2352x1568 — 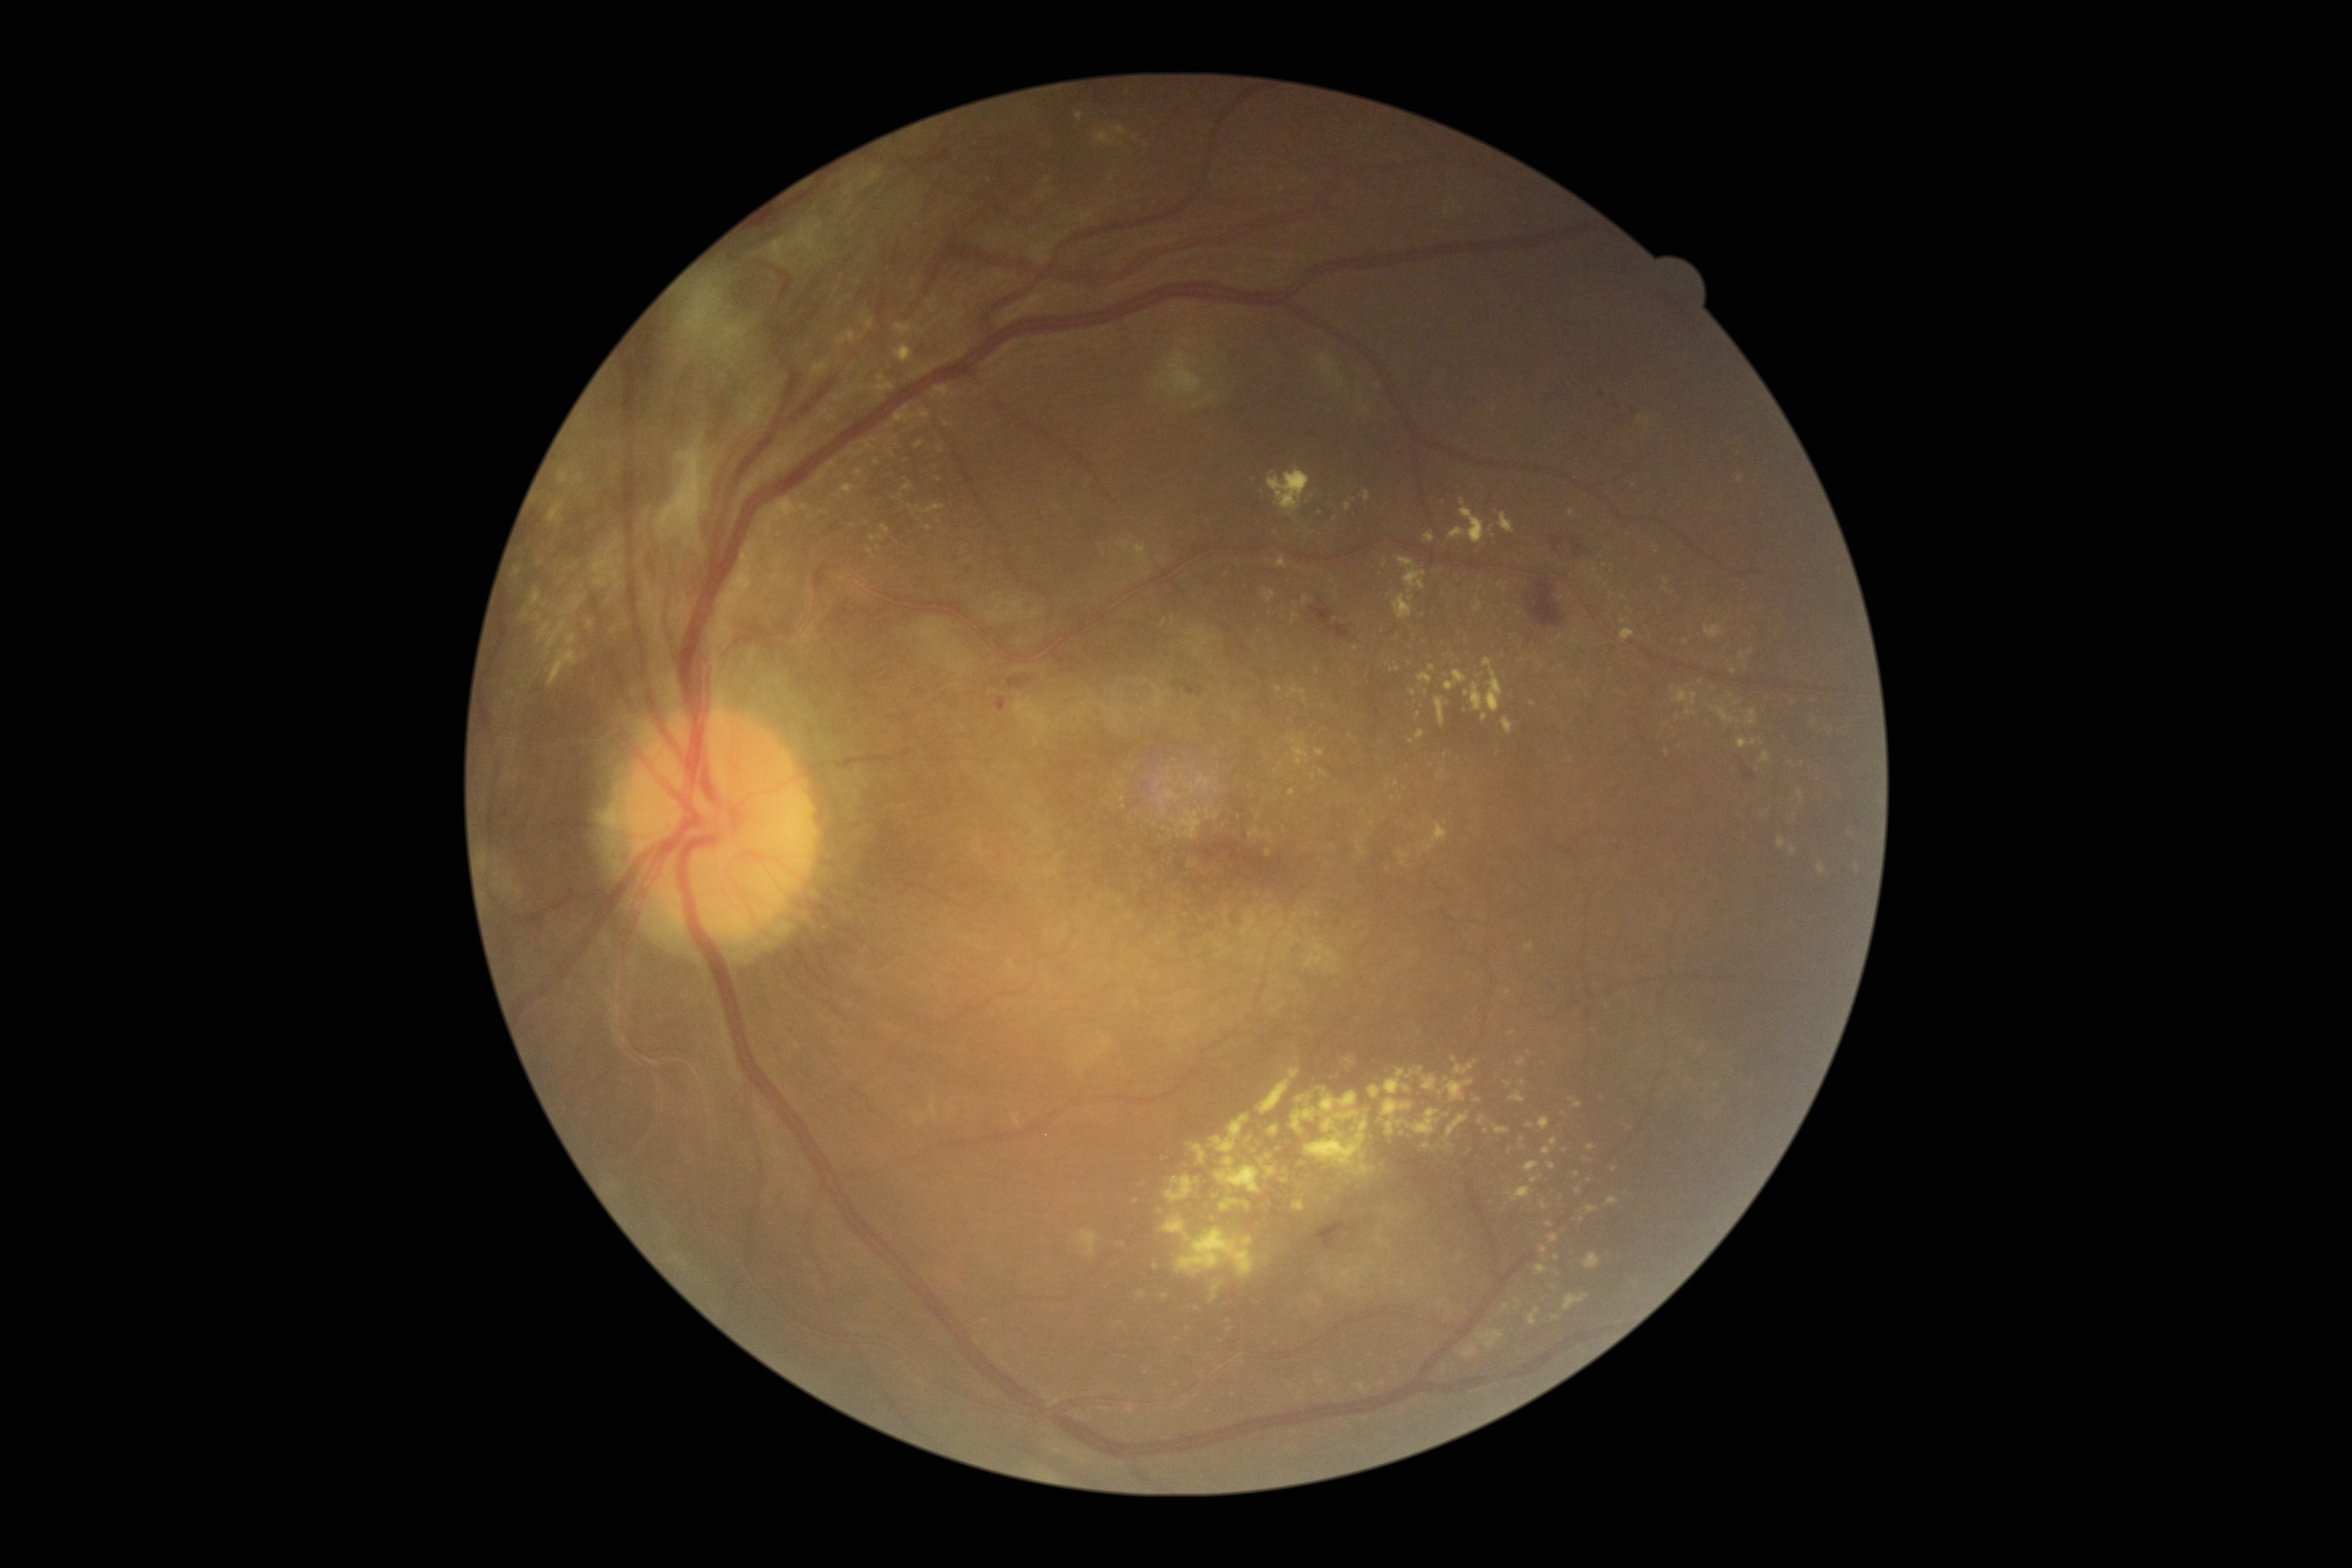

Diabetic retinopathy grade is 4 (PDR) — neovascularization and/or vitreous/pre-retinal hemorrhage
Representative lesions:
• hard exudates (partial): left=1509, top=1091, right=1525, bottom=1103; left=1422, top=1074, right=1438, bottom=1091; left=1760, top=751, right=1771, bottom=764; left=1549, top=1233, right=1559, bottom=1242; left=1478, top=1116, right=1485, bottom=1126; left=1382, top=1099, right=1414, bottom=1135; left=1423, top=822, right=1448, bottom=851; left=1586, top=1204, right=1599, bottom=1213; left=834, top=331, right=857, bottom=349; left=1740, top=653, right=1746, bottom=662
• Smaller hard exudates around x=1411, y=742; x=1326, y=1279; x=1305, y=600; x=836, y=463; x=1134, y=138; x=1313, y=776; x=1803, y=764; x=1700, y=682; x=888, y=444